Wide-field contact fundus photograph of an infant · acquired on the Clarity RetCam 3:
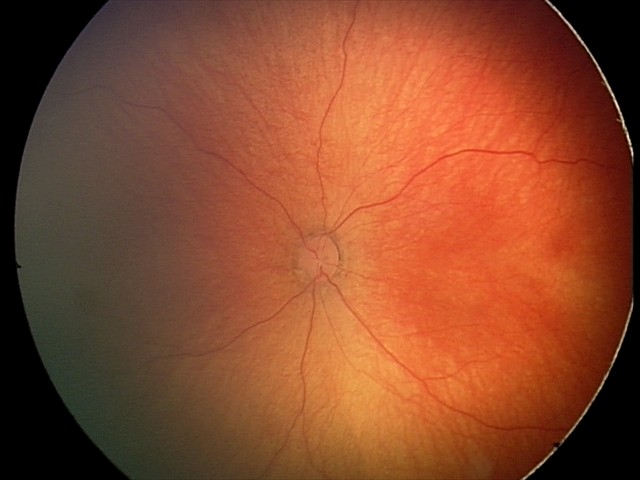
From an examination with diagnosis of retinal hemorrhages.